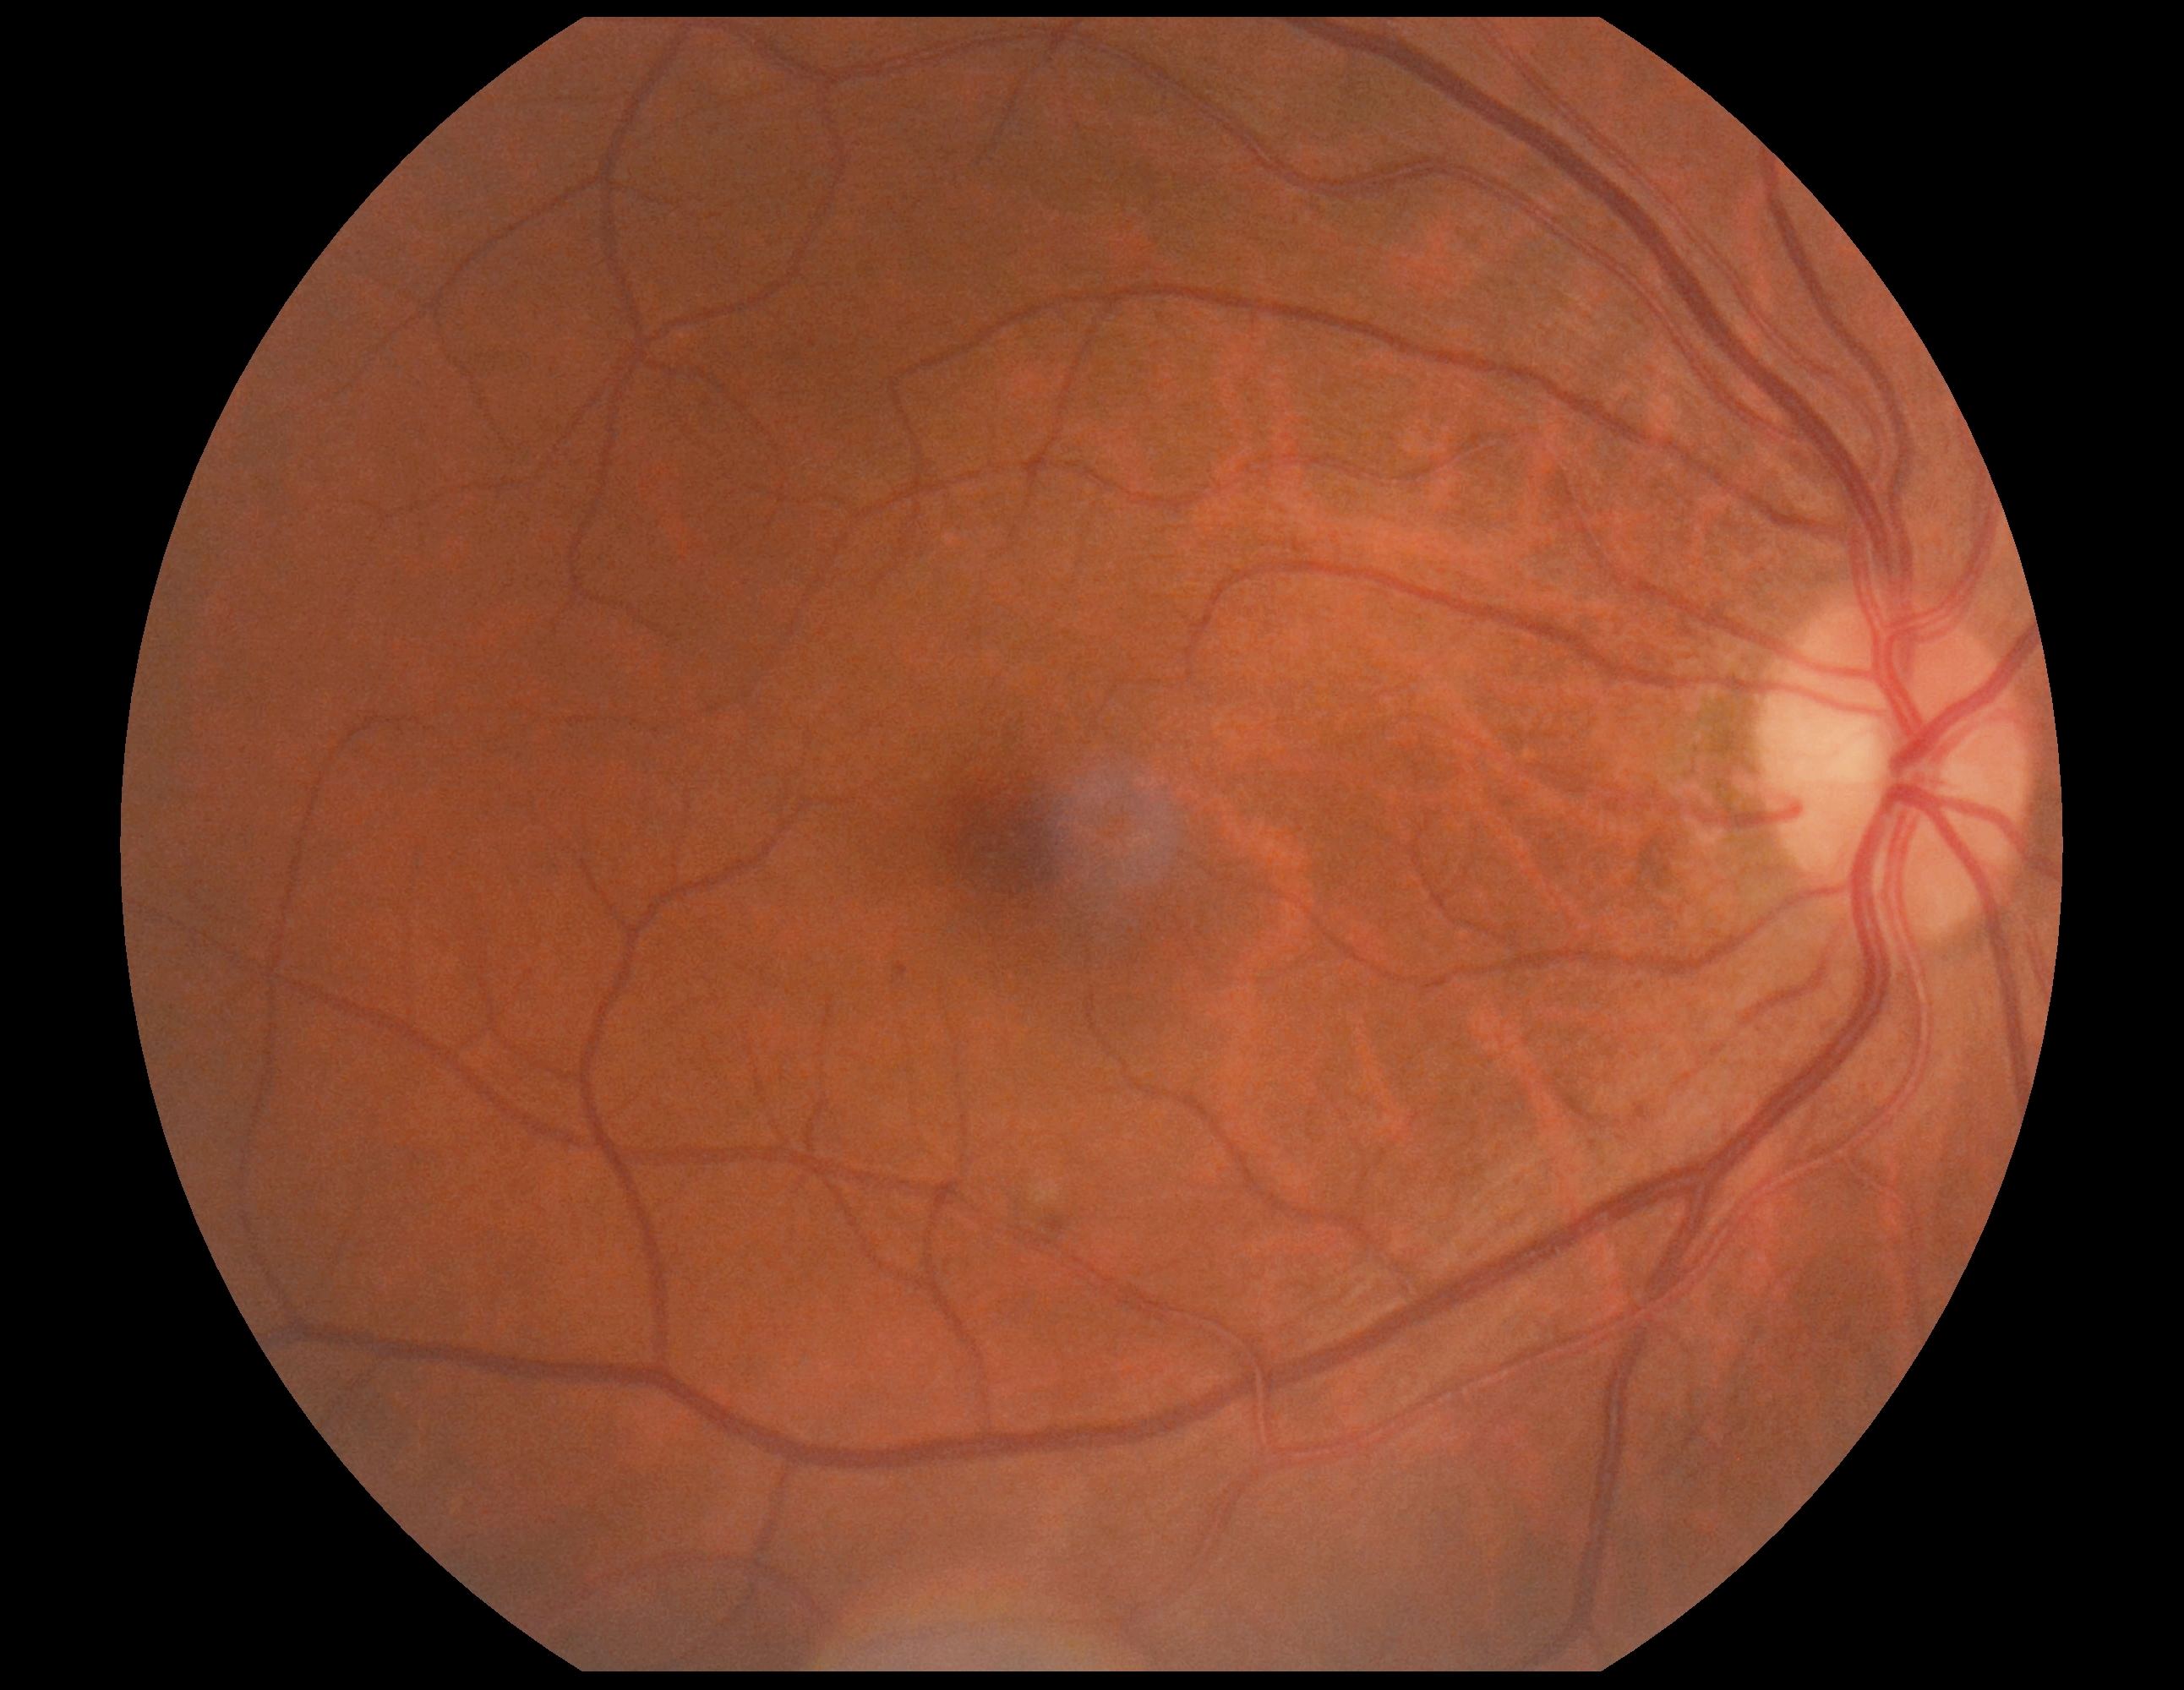 DR severity: 2.